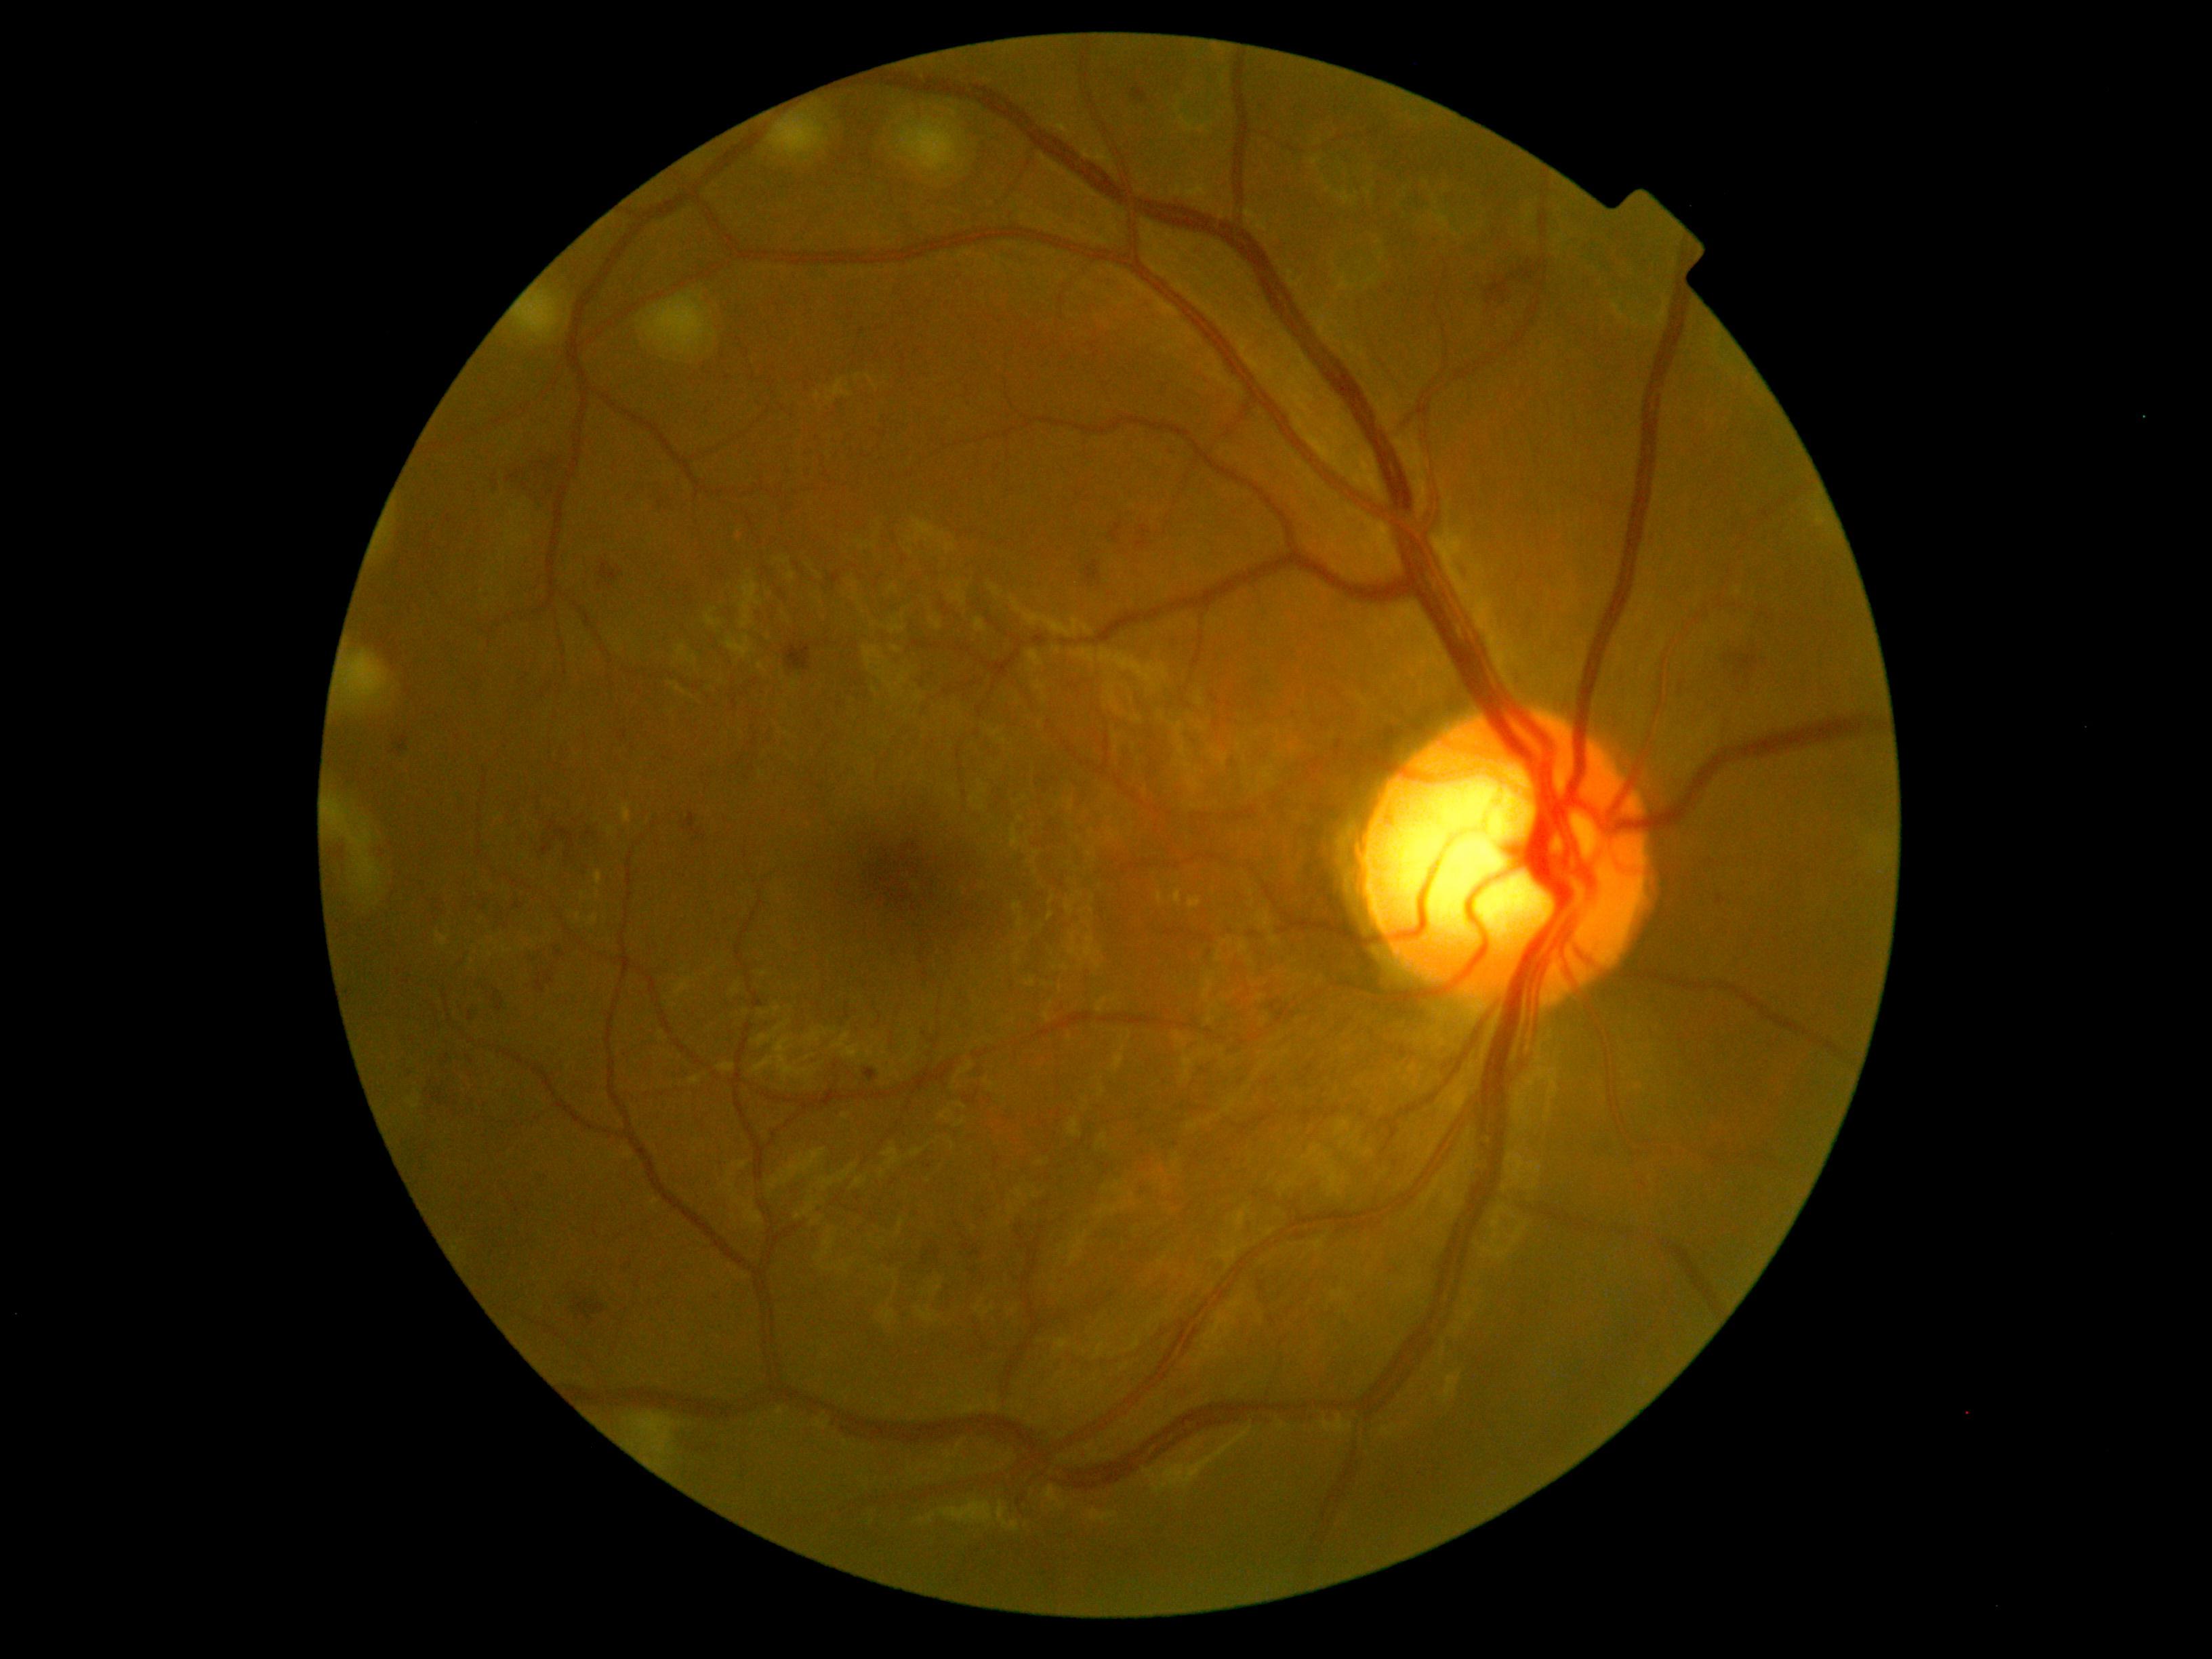
retinopathy grade@2 — more than just microaneurysms but less than severe NPDR.